Graded on the modified Davis scale:
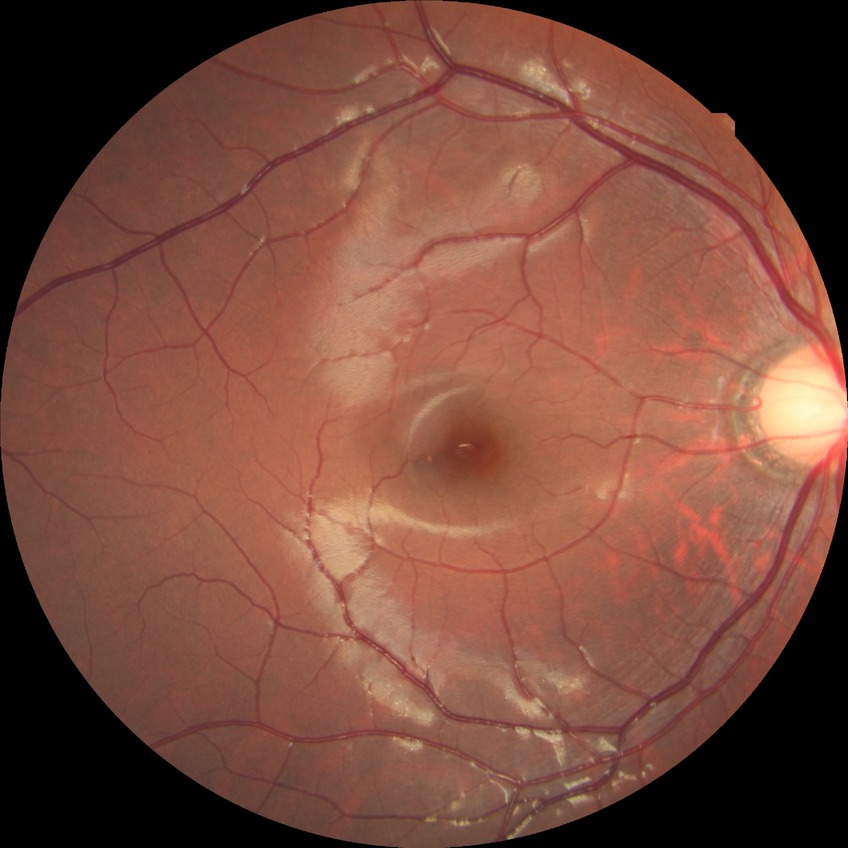

DR impression = no apparent DR, modified Davis grade = NDR.